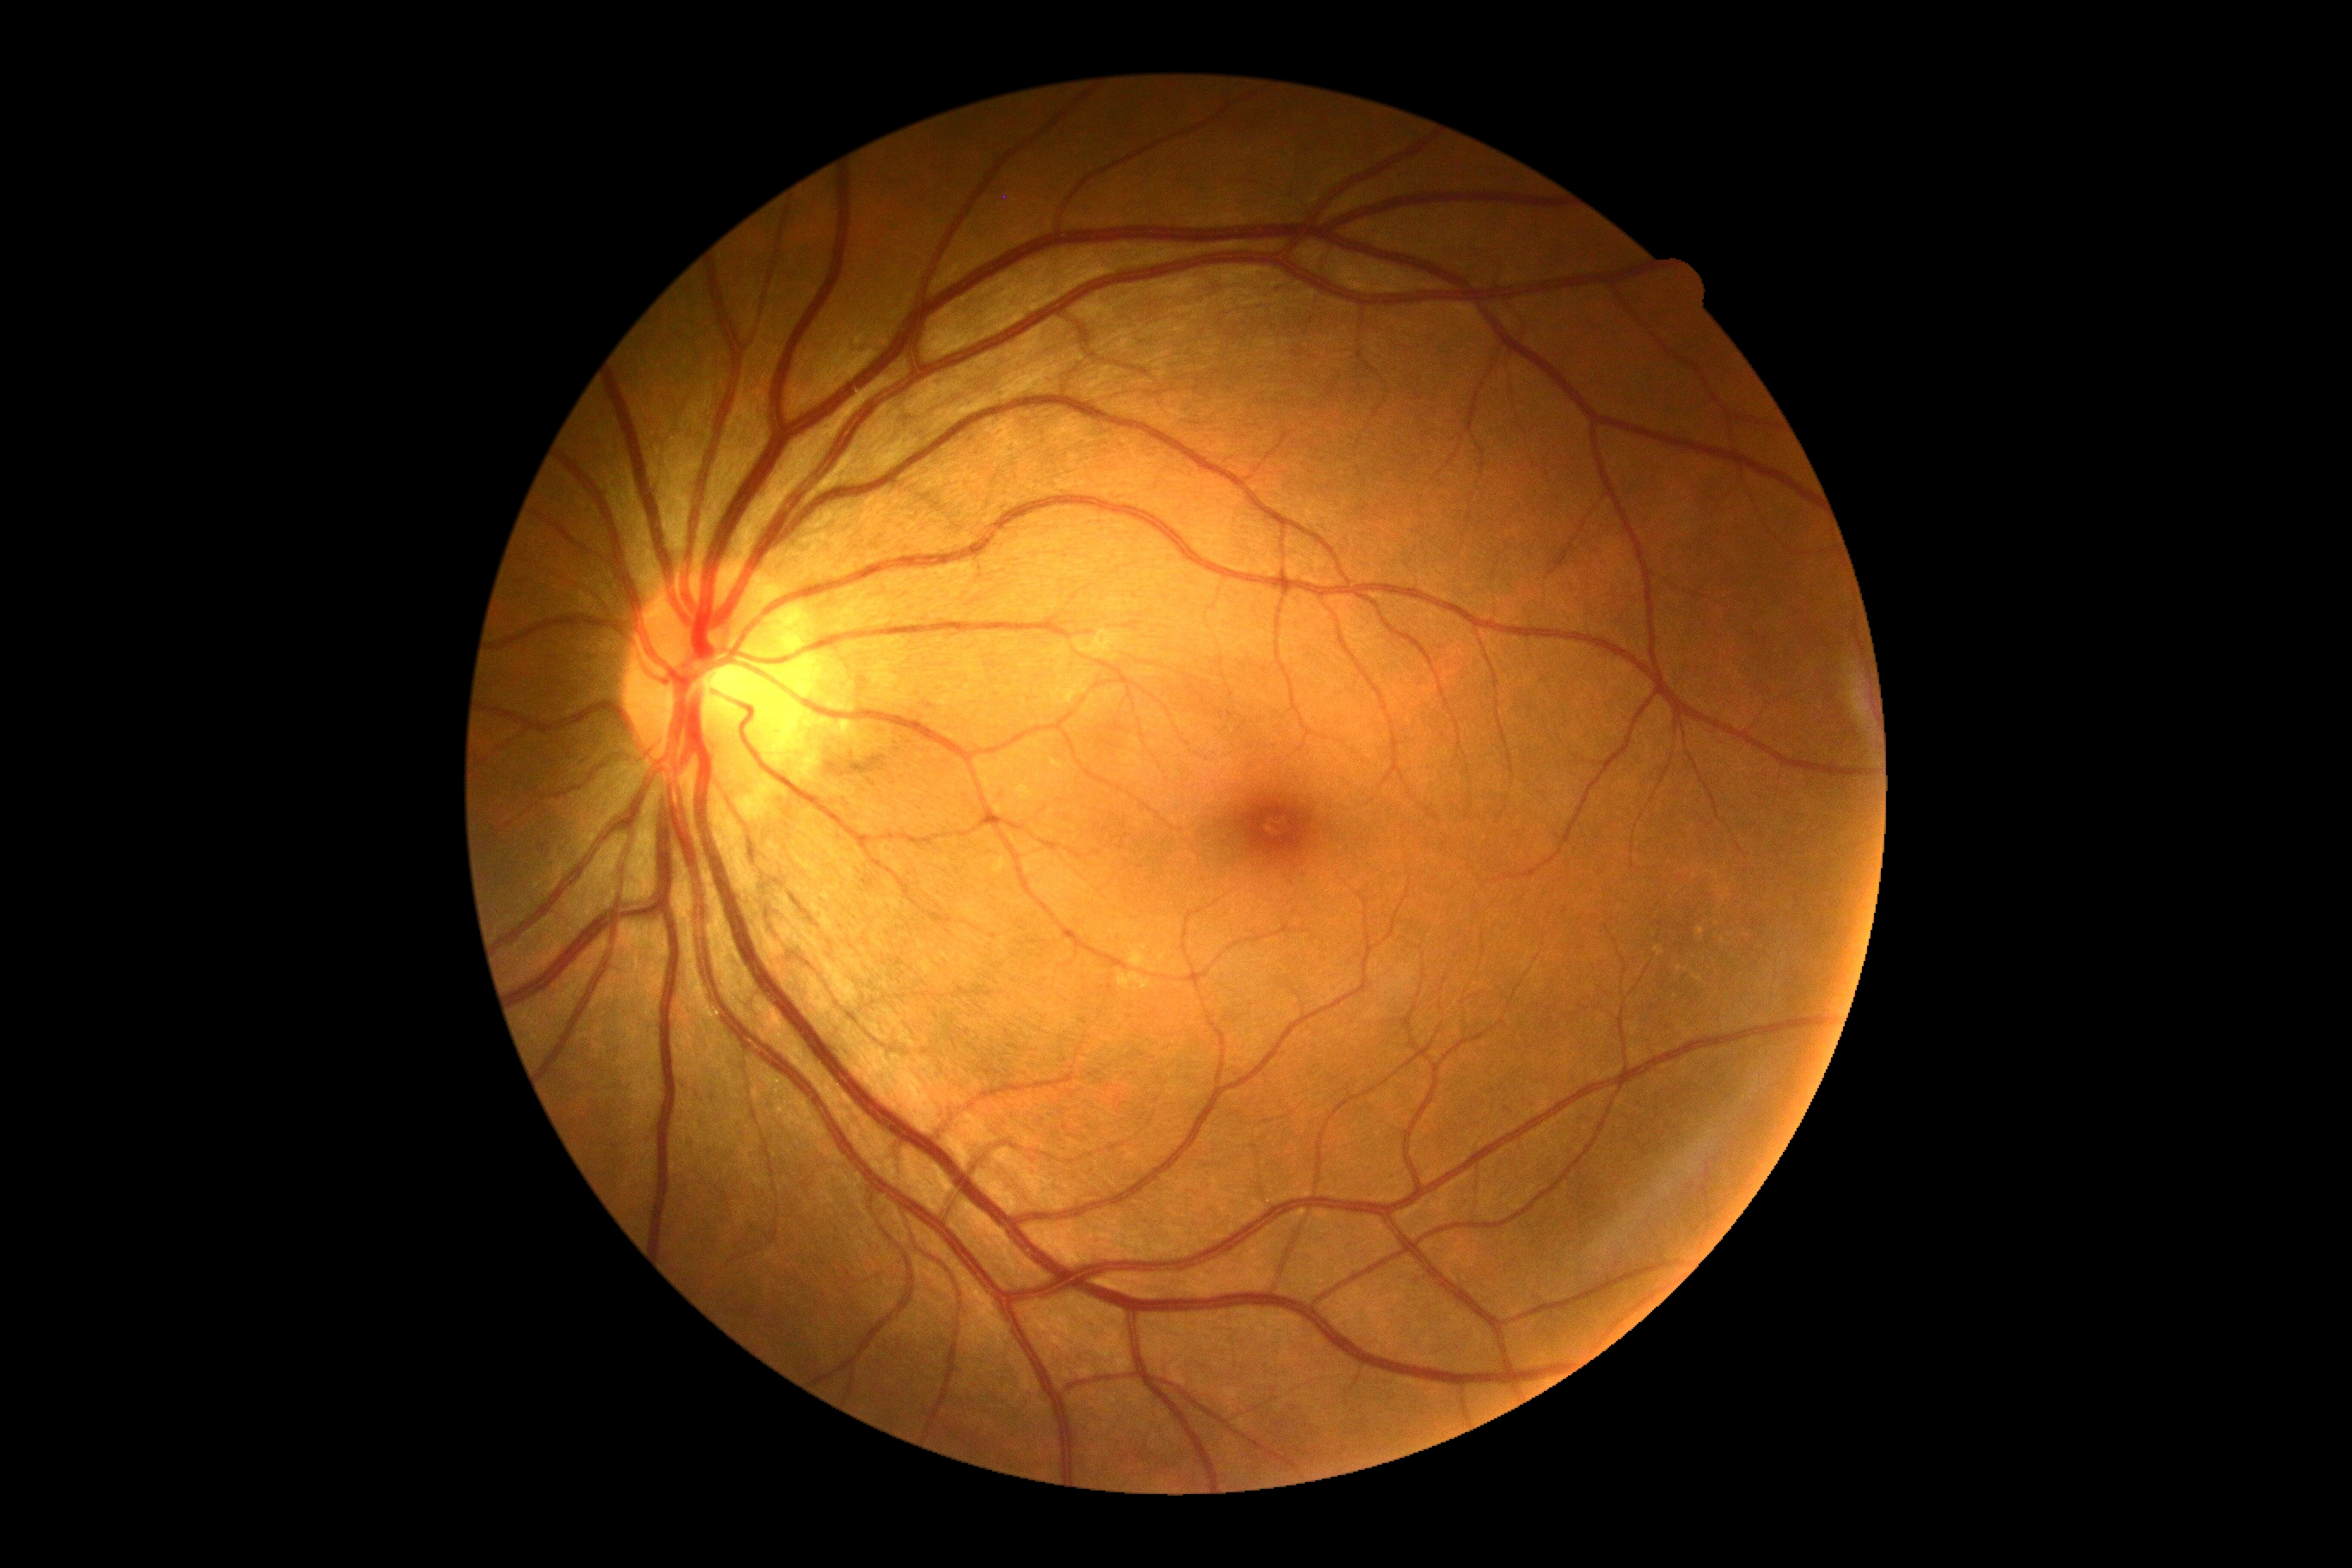

DR stage is 0 — no visible signs of diabetic retinopathy.
No diabetic retinal disease findings.